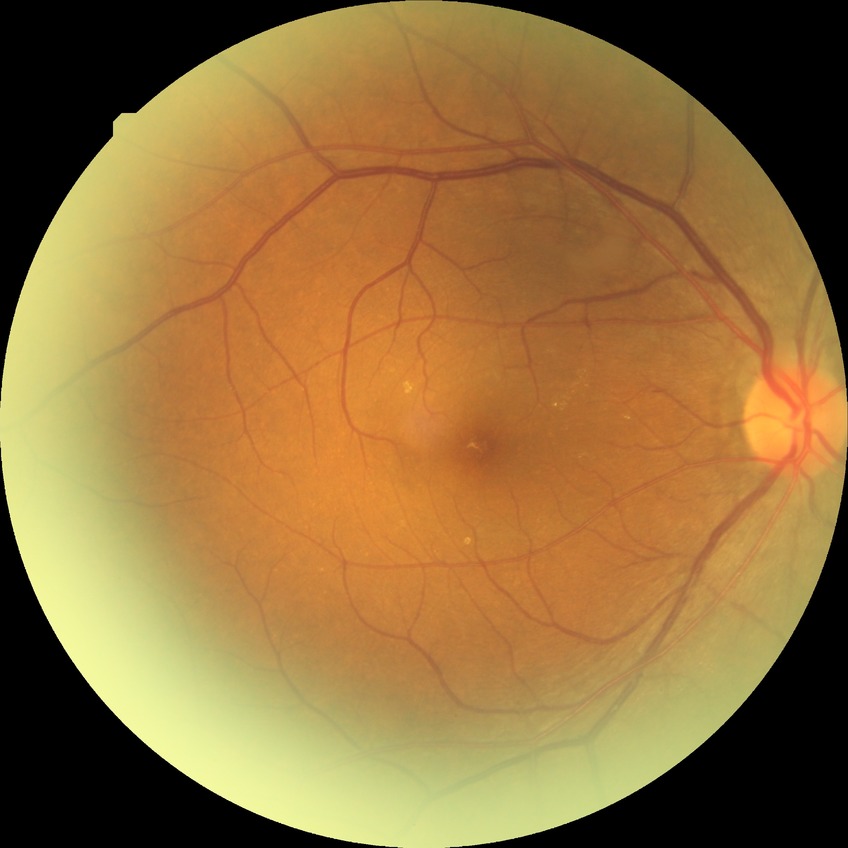 diabetic retinopathy (DR) = no diabetic retinopathy (NDR)